45° field of view — 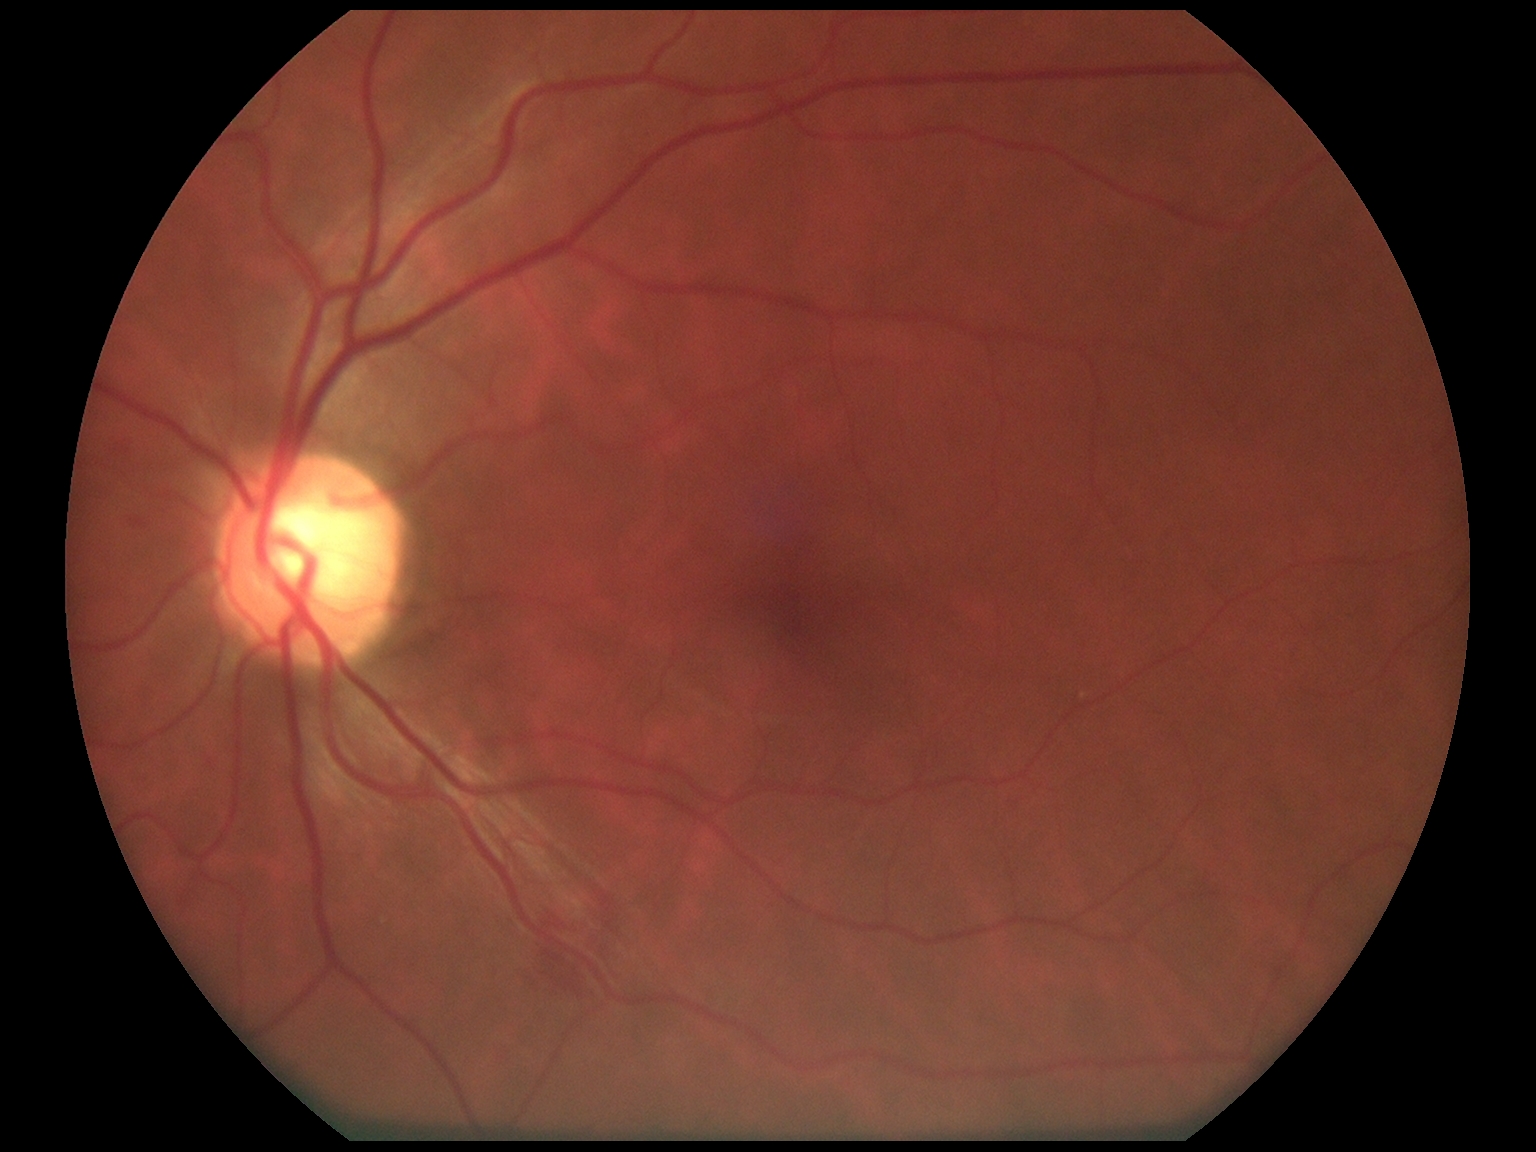

Annotations:
* DR class — non-proliferative diabetic retinopathy
* DR grade — 2 (moderate NPDR)